Wide-field fundus image from infant ROP screening · 640x480 · 130° field of view (Clarity RetCam 3)
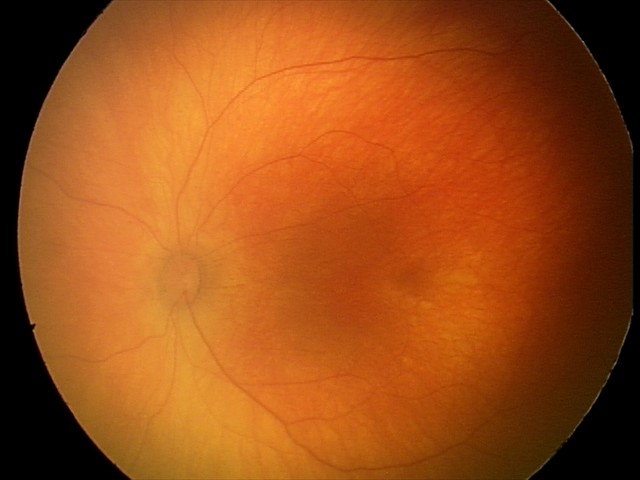

Screening examination with no abnormal retinal findings.